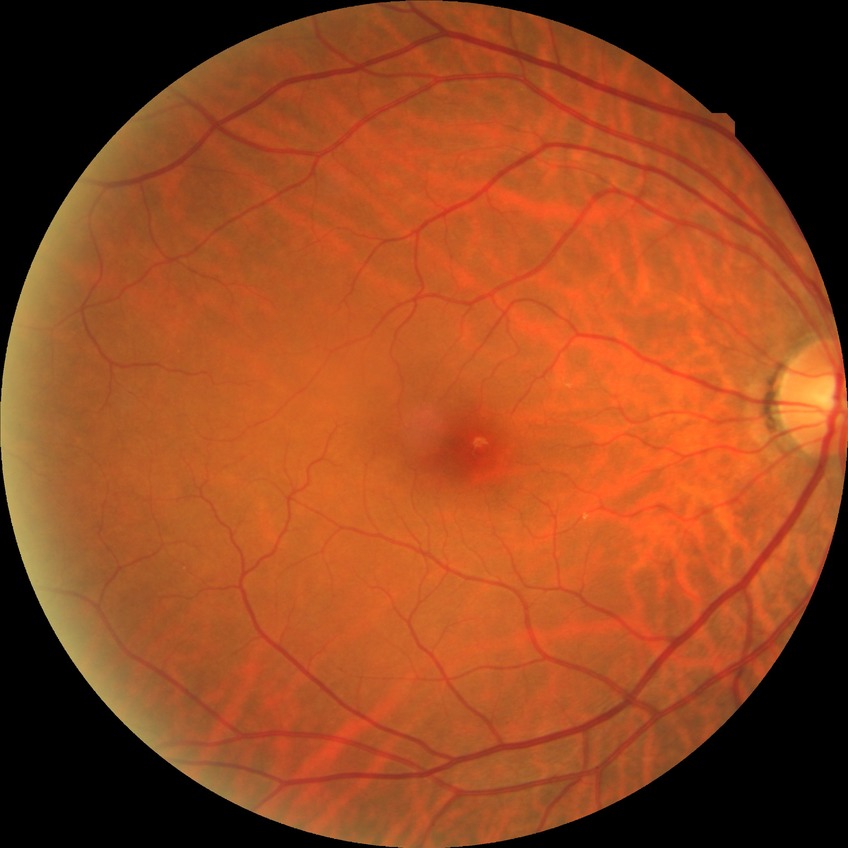 Diabetic retinopathy (DR) is NDR (no diabetic retinopathy).